Color fundus photograph; 50° FOV: 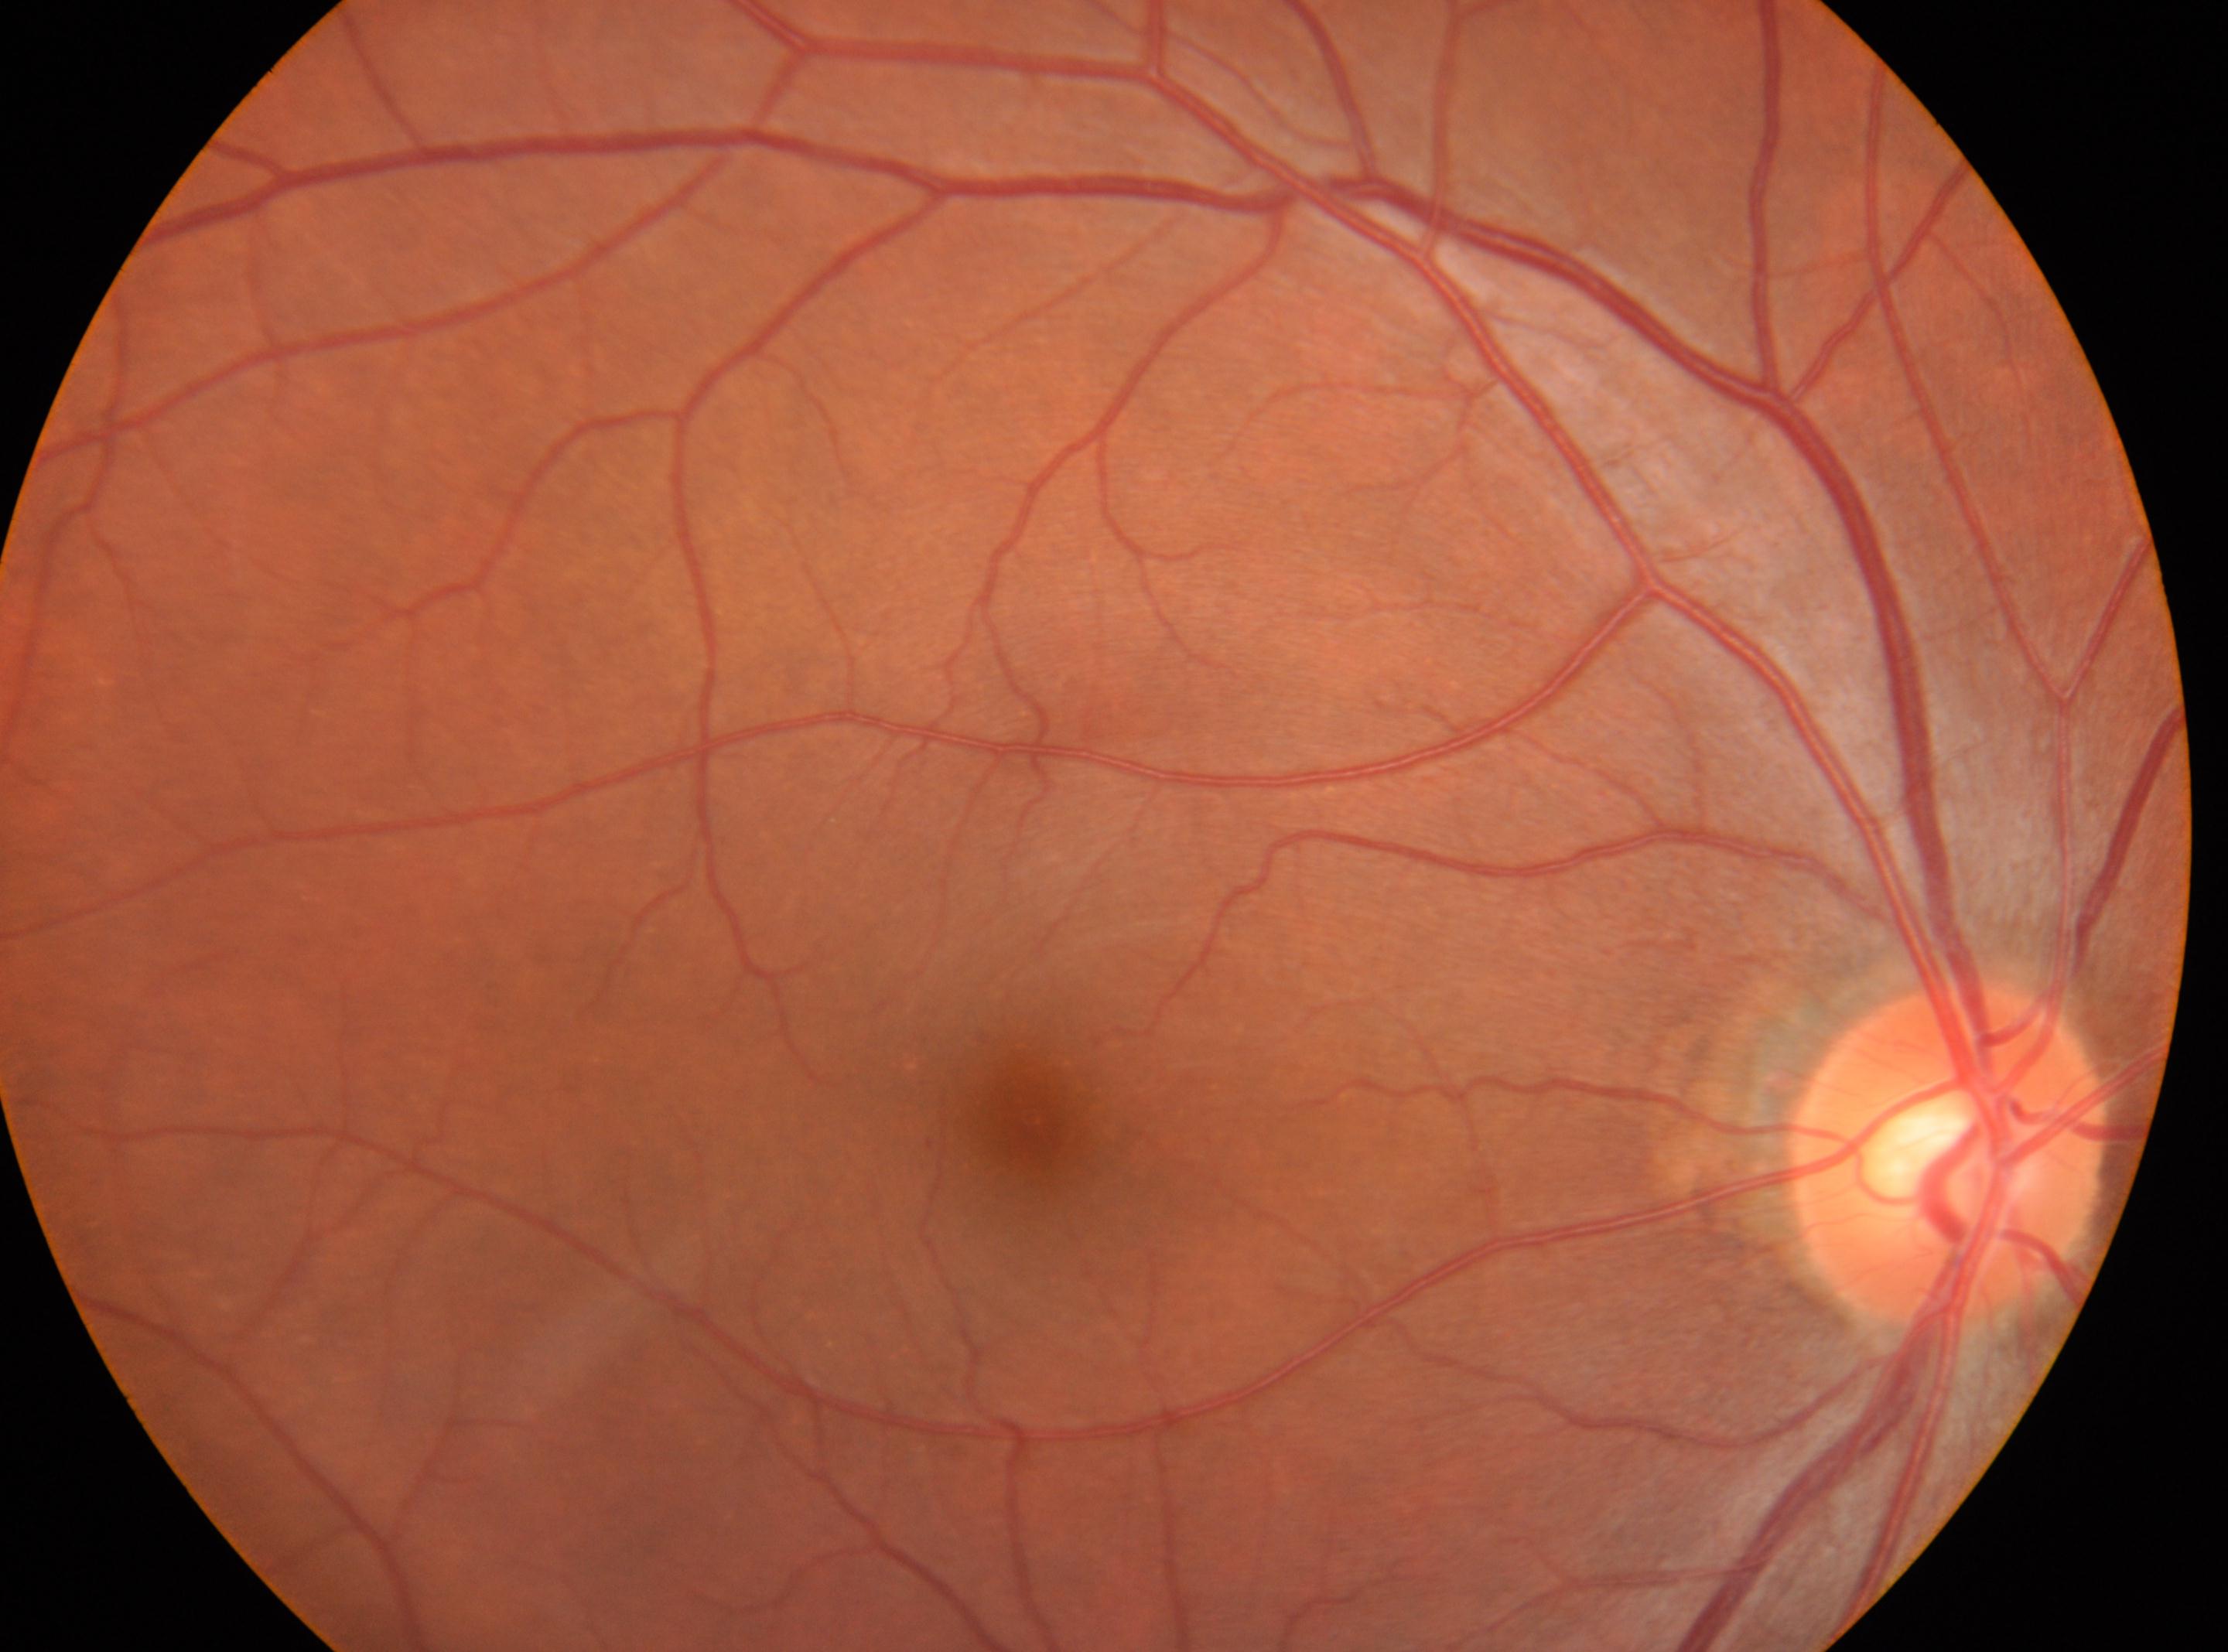

The optic disc is at (x=1946, y=1153). No signs of diabetic retinopathy. DR grade is 0 (no apparent retinopathy). Imaged eye: OD. Foveal center: (x=1029, y=1117).